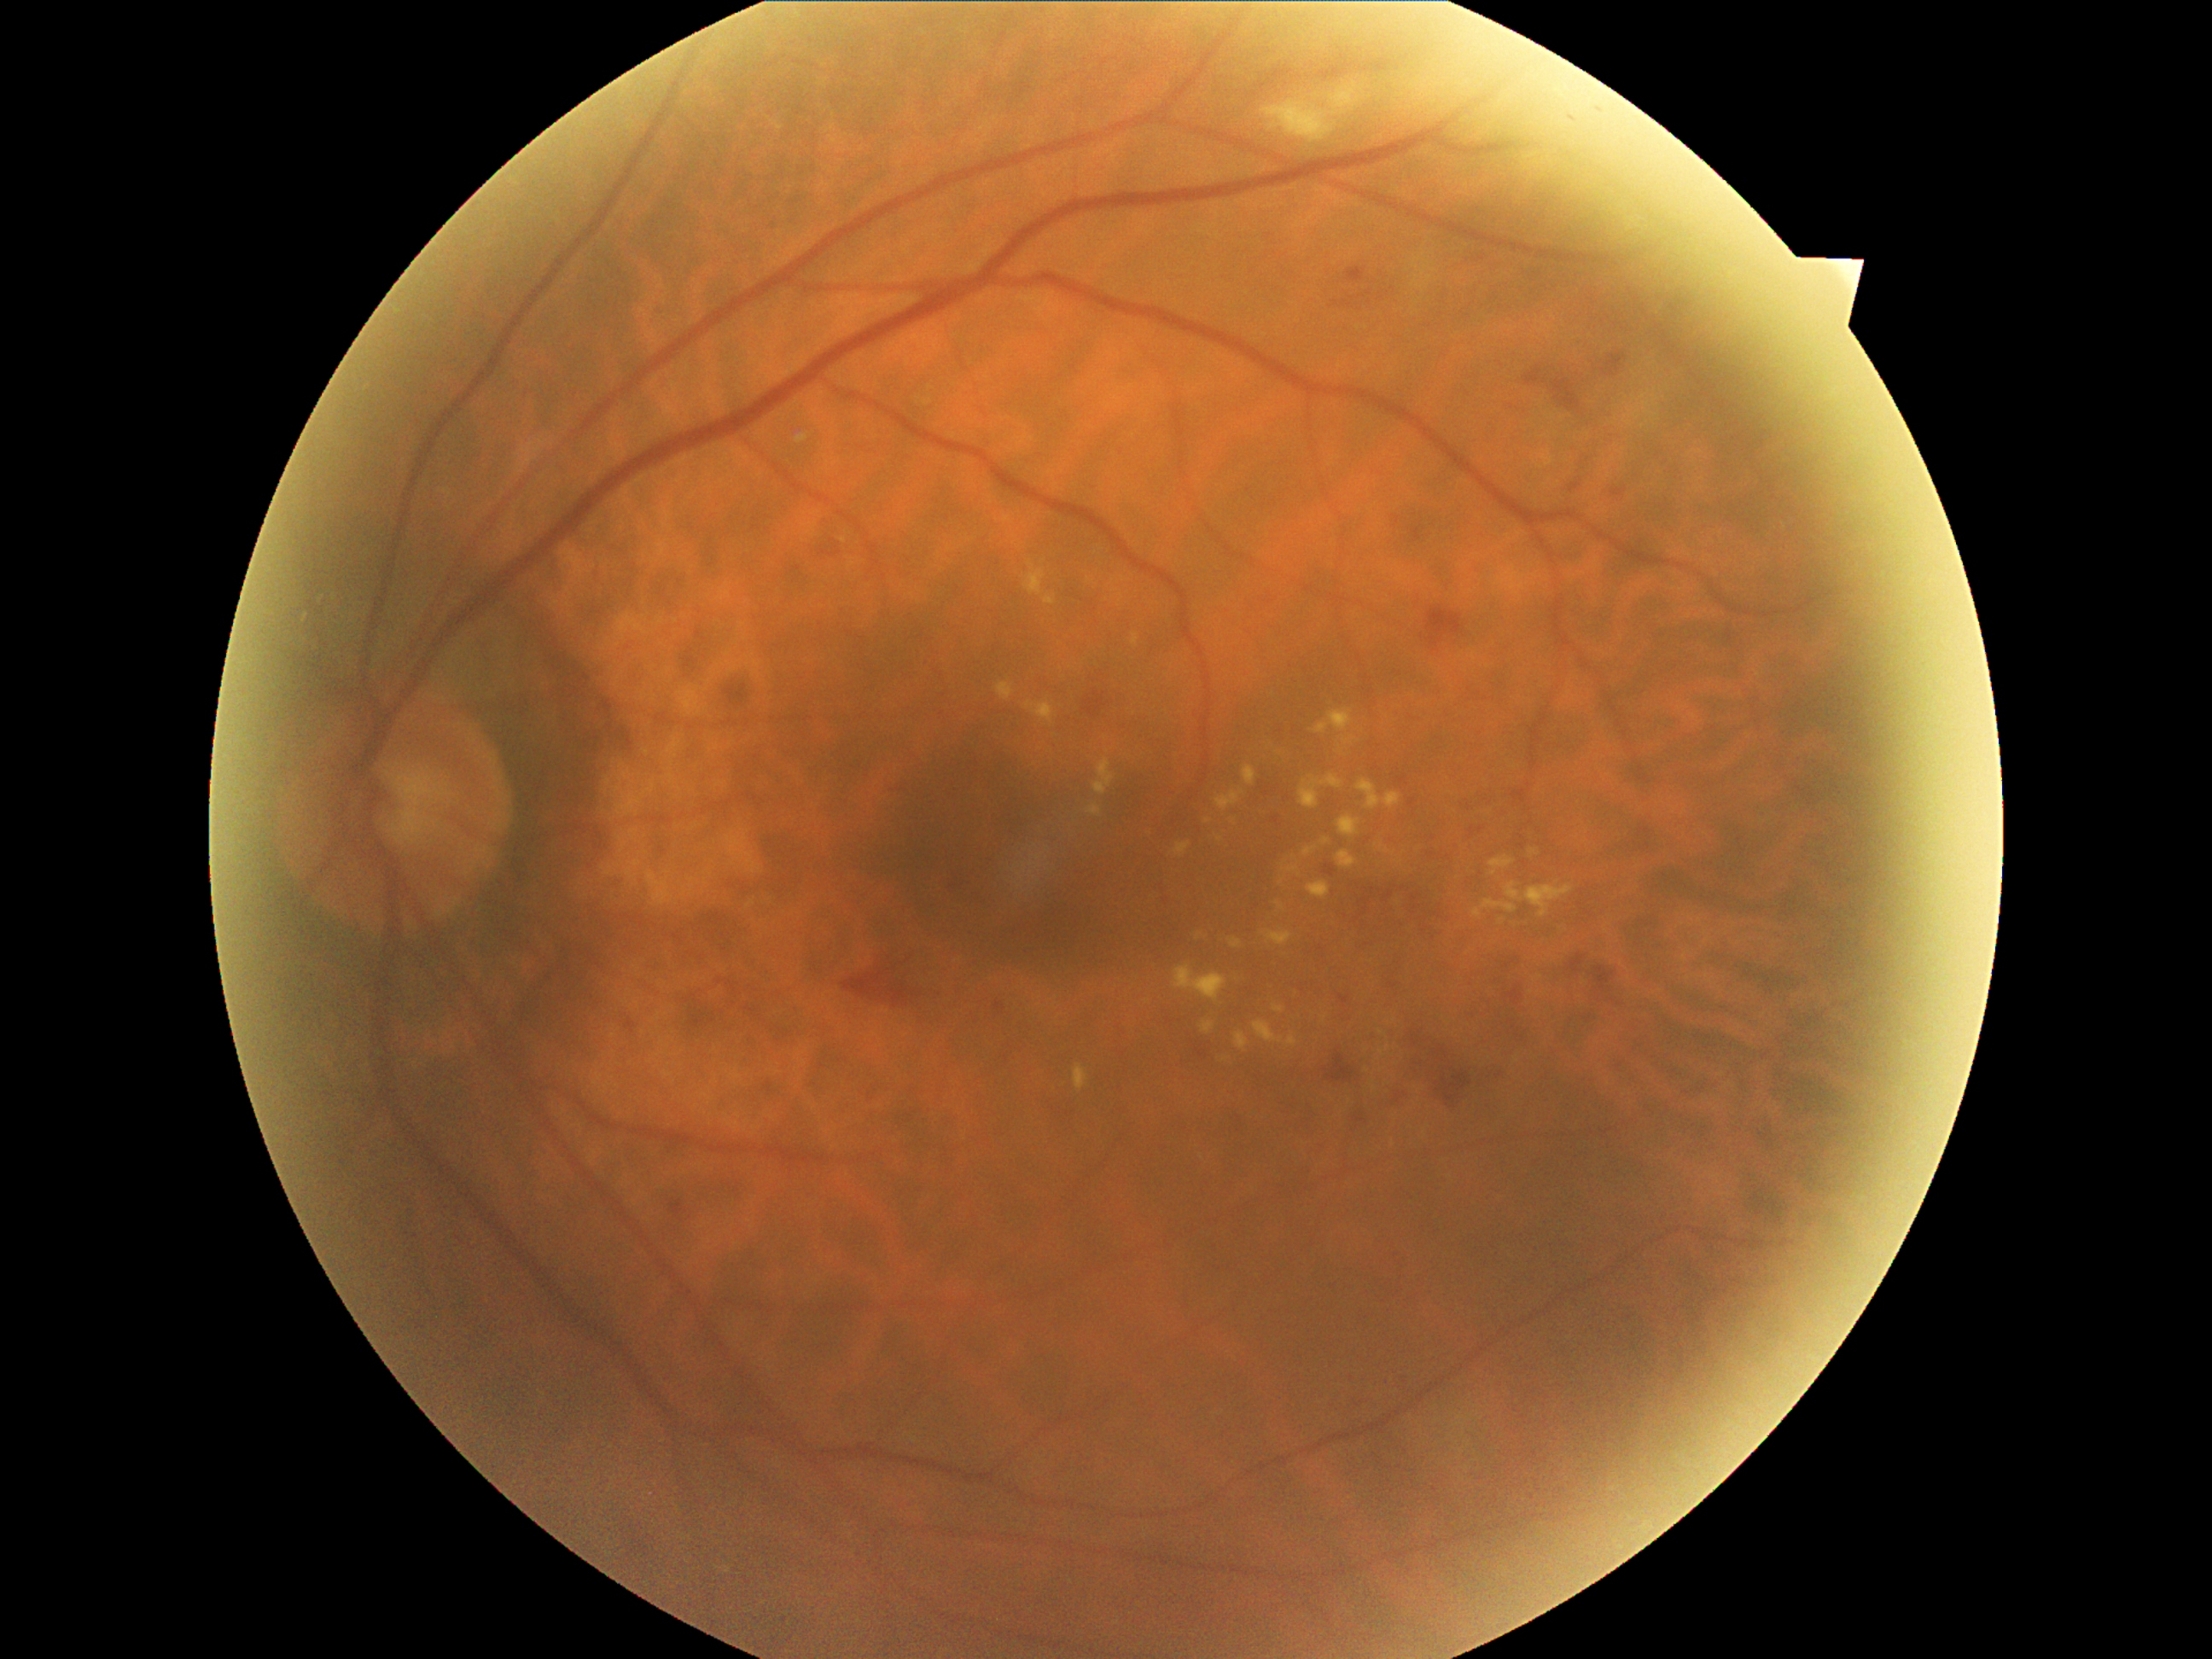 partial: true
dr_grade: 2
dr_grade_name: moderate NPDR
lesions:
  se:
    - bbox=[1260, 83, 1366, 144]
  ex:
    - bbox=[1201, 1022, 1214, 1033]
    - bbox=[1288, 868, 1300, 873]
    - bbox=[1491, 856, 1515, 876]
    - bbox=[1074, 1064, 1088, 1091]
    - bbox=[1286, 1035, 1298, 1045]
    - bbox=[1254, 1020, 1284, 1044]
    - bbox=[1243, 765, 1257, 786]
    - bbox=[1315, 707, 1353, 735]
    - bbox=[1272, 1004, 1284, 1013]
    - bbox=[1237, 1032, 1250, 1049]
    - bbox=[1505, 883, 1575, 917]
    - bbox=[1025, 701, 1057, 723]
  ex_small_approx:
    - (1502, 920)
    - (1325, 1018)
    - (1220, 839)
  he:
    - bbox=[1086, 697, 1105, 718]
    - bbox=[1348, 267, 1366, 282]
    - bbox=[890, 986, 907, 1004]
    - bbox=[1525, 370, 1540, 385]
    - bbox=[1554, 380, 1581, 407]
    - bbox=[1610, 356, 1624, 376]
    - bbox=[1595, 967, 1614, 991]
    - bbox=[1423, 1052, 1450, 1073]
    - bbox=[1428, 607, 1462, 646]
    - bbox=[1395, 1085, 1417, 1105]
    - bbox=[1508, 989, 1522, 1004]
    - bbox=[1329, 1049, 1354, 1083]
    - bbox=[1571, 955, 1585, 974]
    - bbox=[842, 970, 887, 998]
    - bbox=[1443, 1074, 1470, 1102]
  he_small_approx:
    - (1095, 694)
  ma:
    - bbox=[1569, 484, 1581, 492]
    - bbox=[670, 1201, 684, 1216]
    - bbox=[1327, 866, 1334, 876]
    - bbox=[1411, 897, 1419, 902]
    - bbox=[1385, 890, 1394, 900]
    - bbox=[1339, 996, 1348, 1003]
    - bbox=[627, 1020, 636, 1033]
    - bbox=[1614, 491, 1626, 498]
    - bbox=[996, 1003, 1006, 1010]
  ma_small_approx:
    - (1599, 111)
    - (1375, 890)
    - (1403, 779)
    - (1359, 1119)
    - (1573, 119)
    - (1413, 802)